FOV: 50 degrees, CFP — 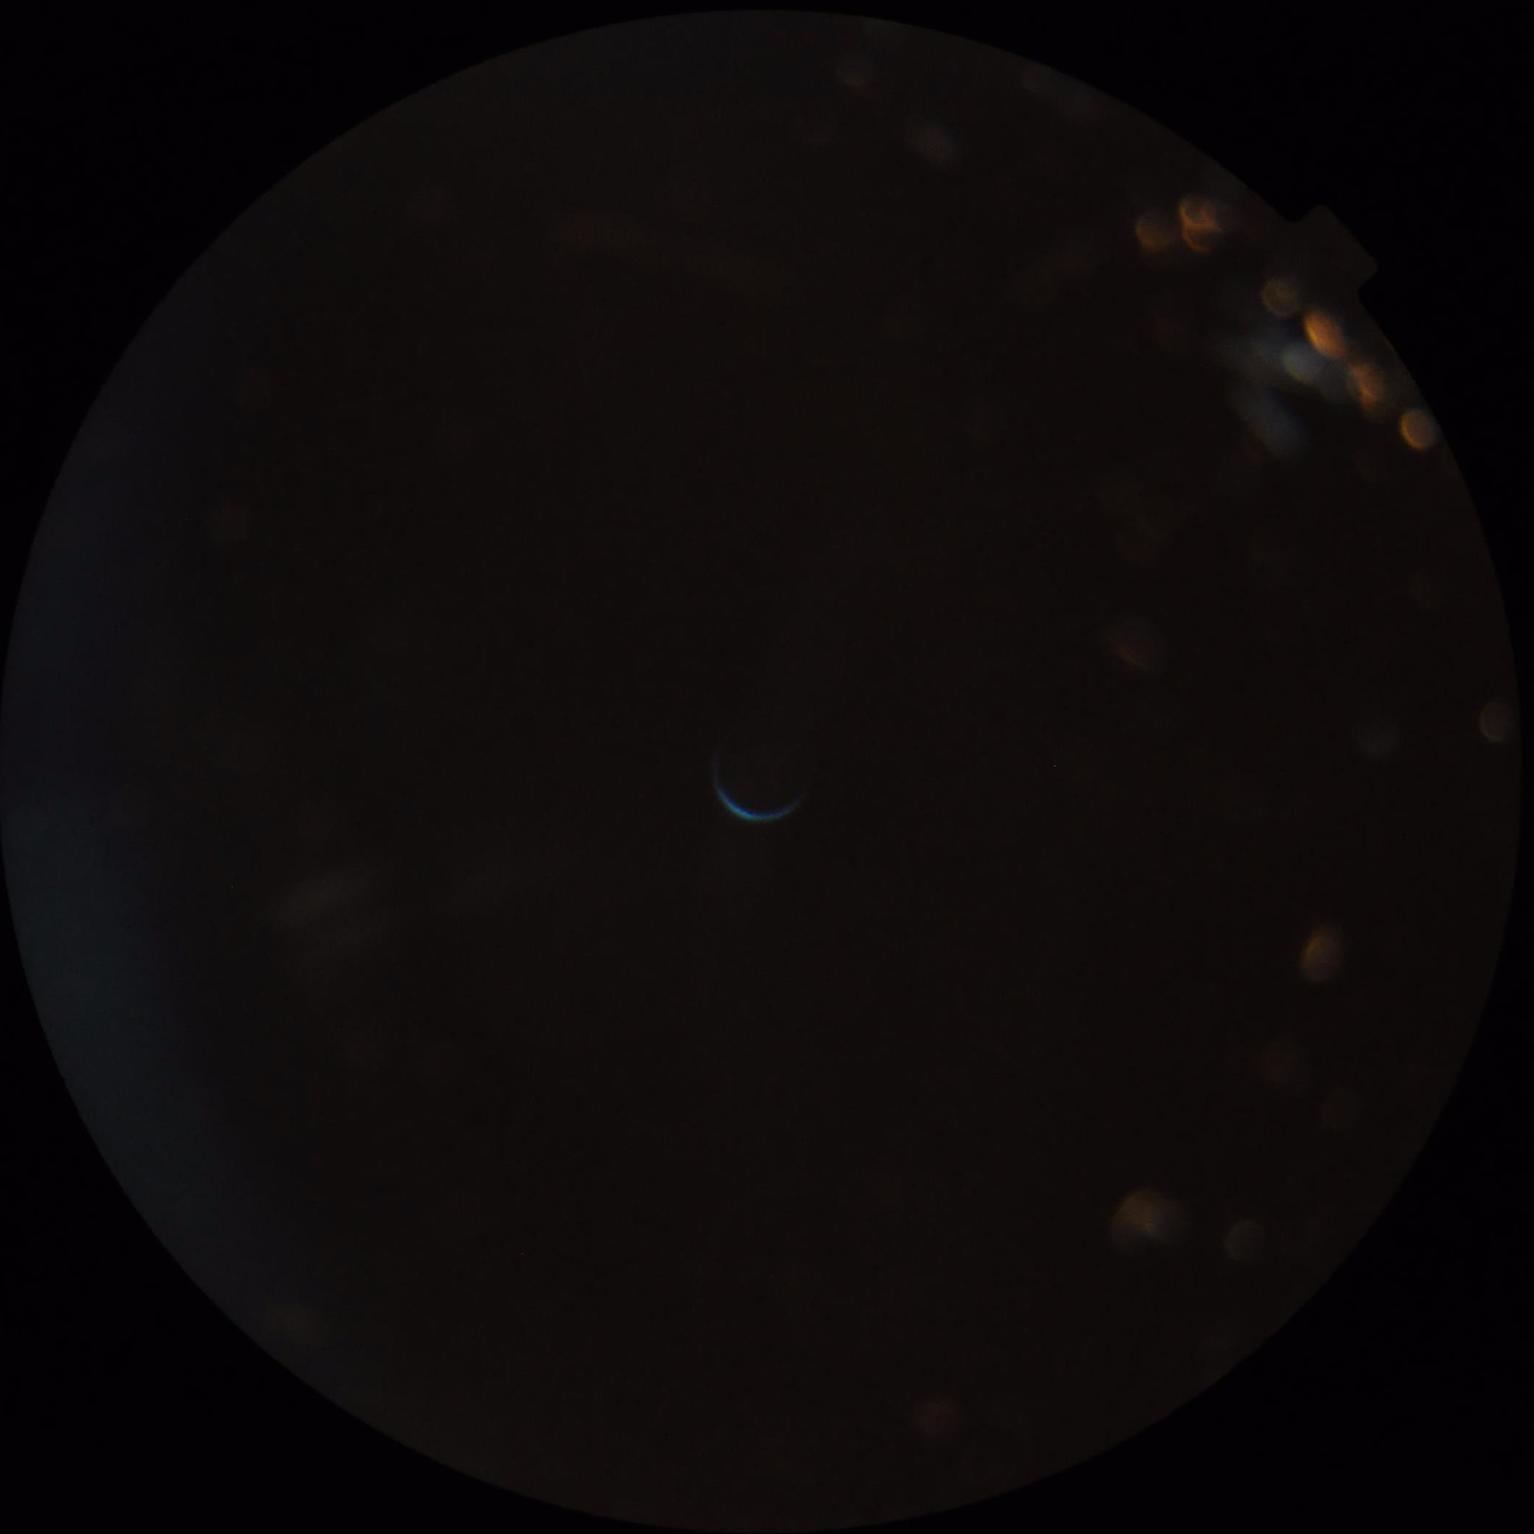
Poor dynamic range.
Reduced sharpness with visible blur.
Poor illumination with uneven exposure.
Overall image quality is poor.